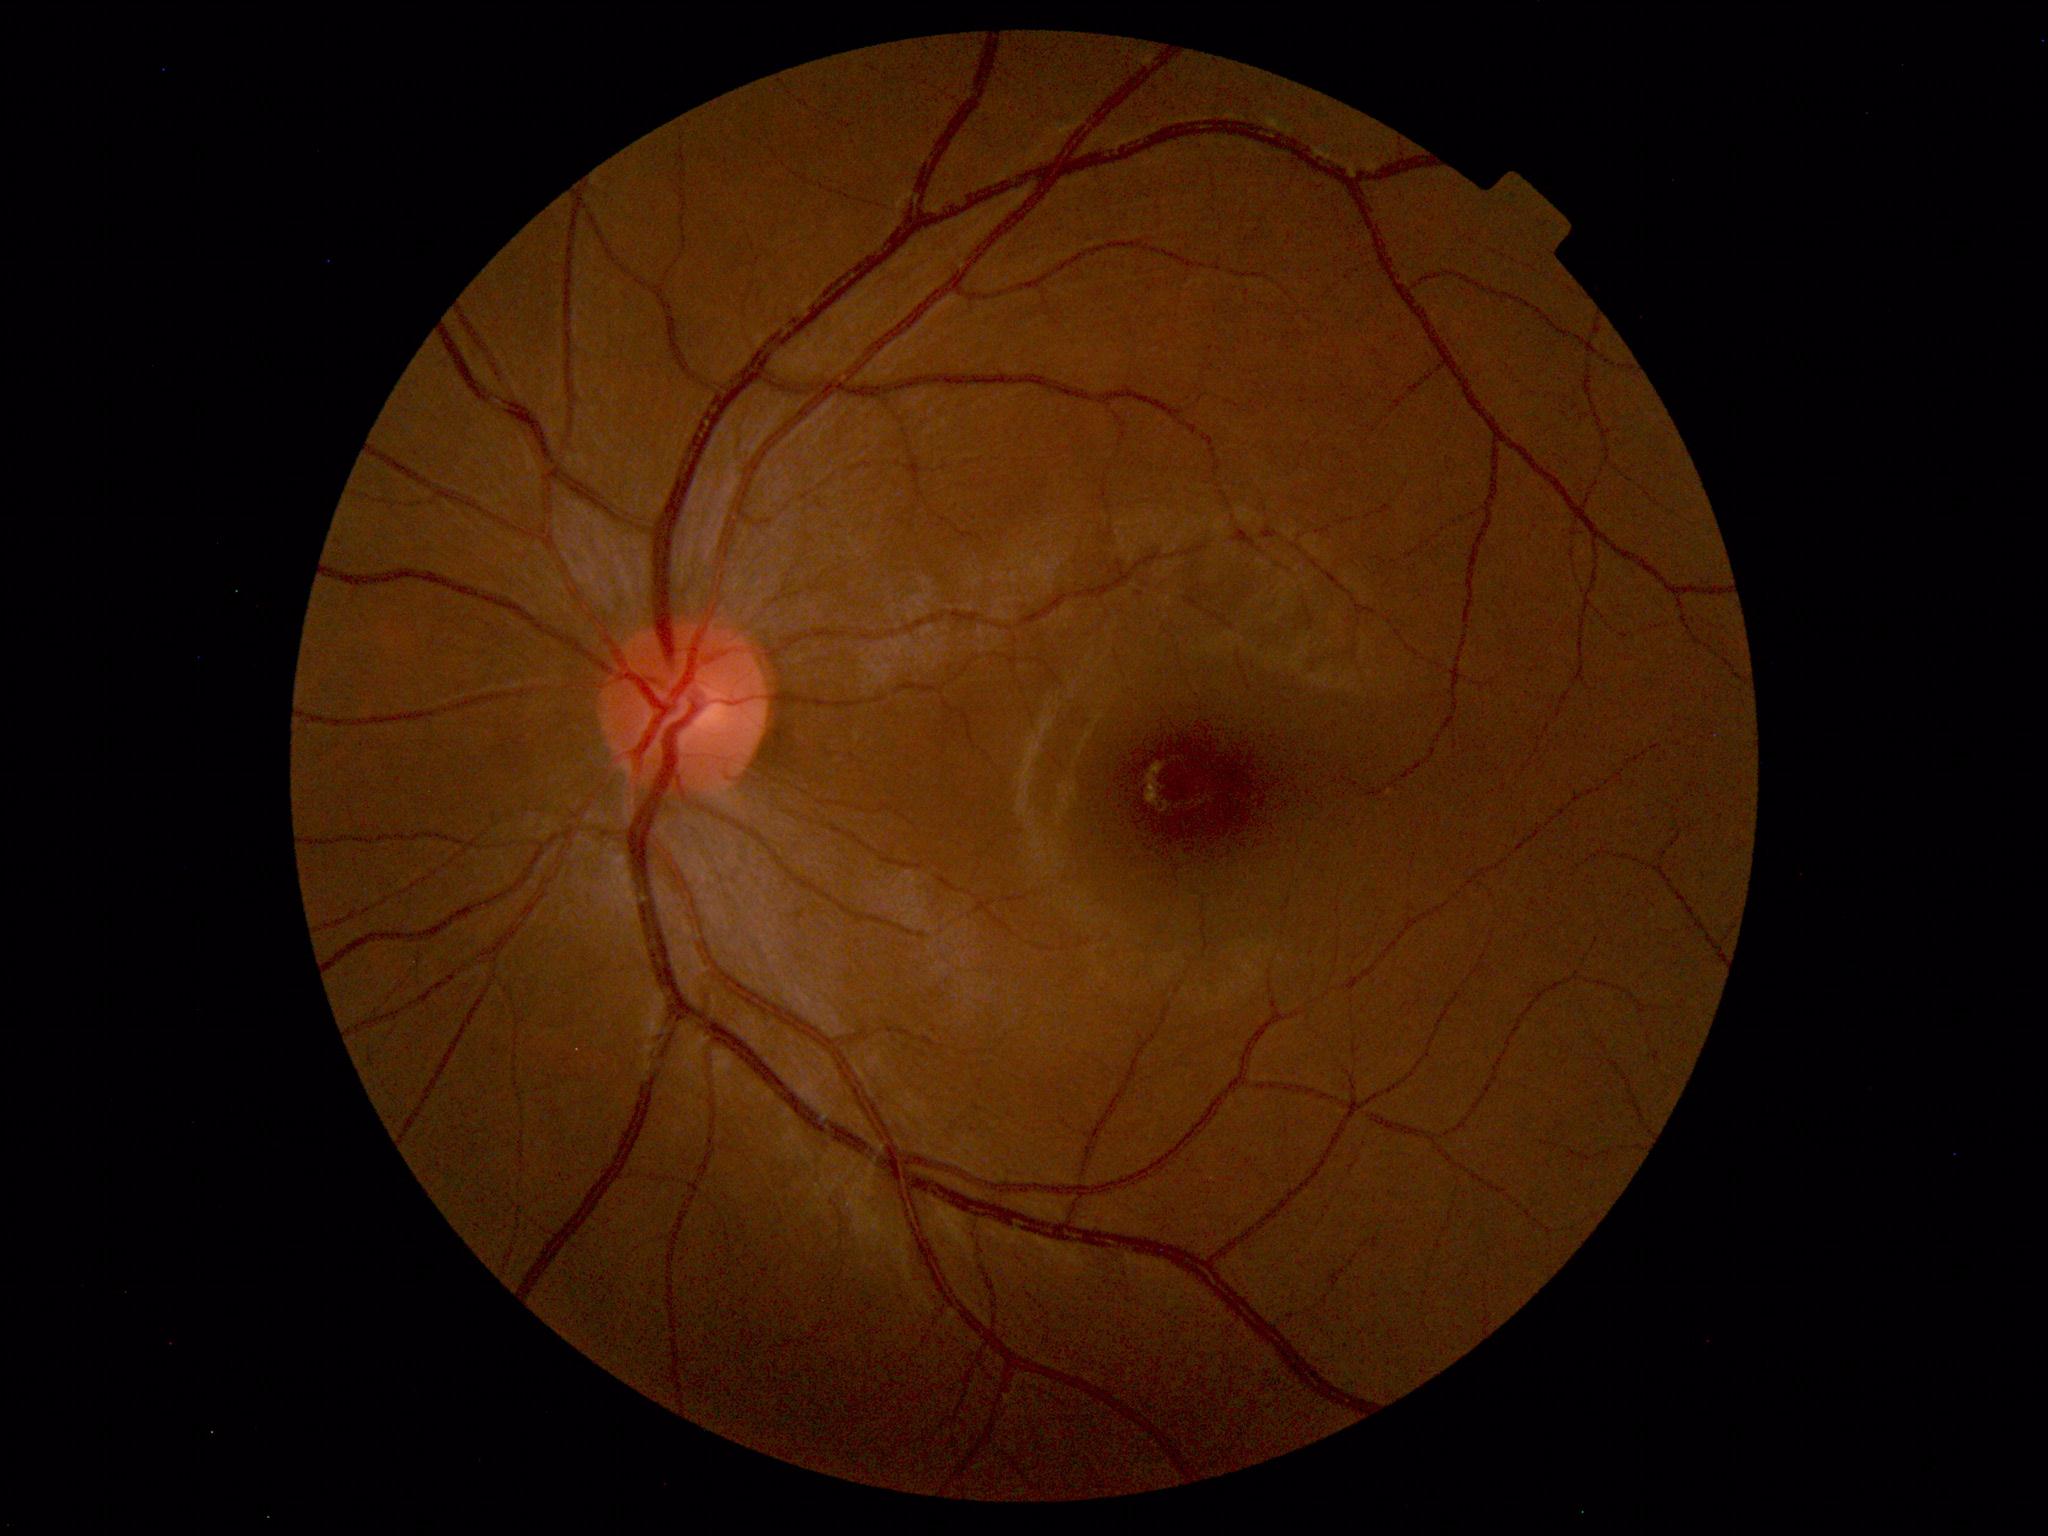

Impression: normal fundus.